Acquired with a Nidek AFC-330:
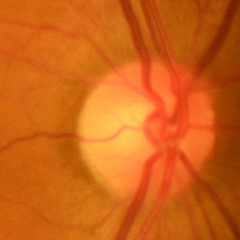
Findings consistent with no glaucomatous changes.